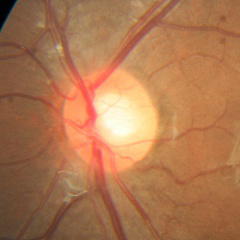
Glaucoma stage: no evidence of glaucoma.